Camera: NIDEK AFC-230; Davis DR grading; 848x848px
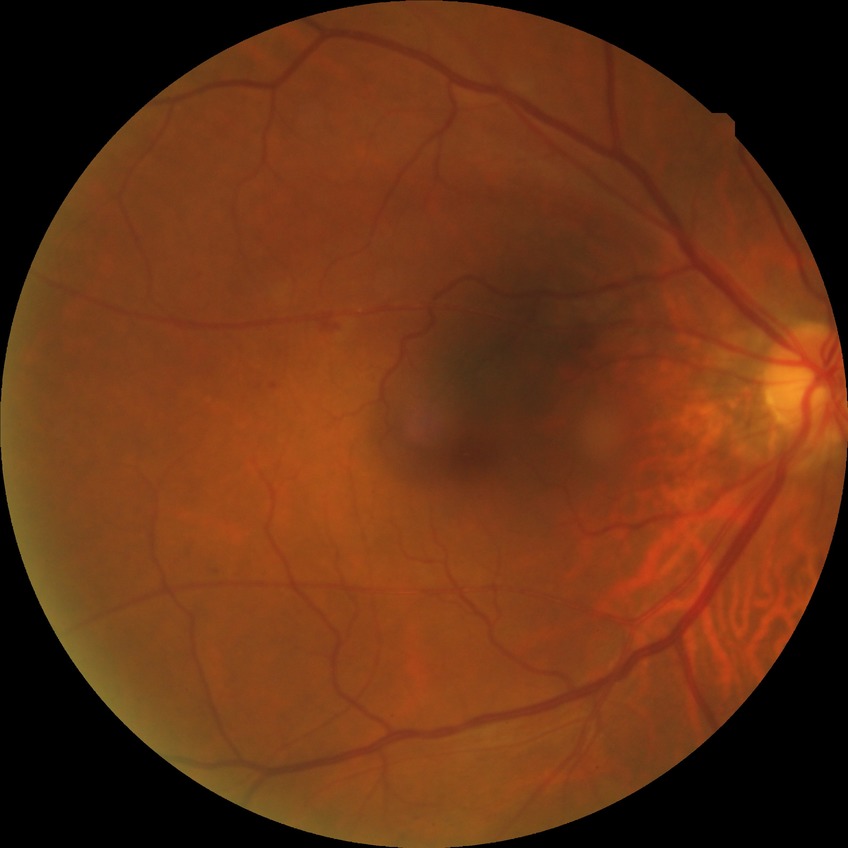 Diabetic retinopathy (DR) is SDR (simple diabetic retinopathy).